Image size 2352x1568. CFP. 45° field of view — 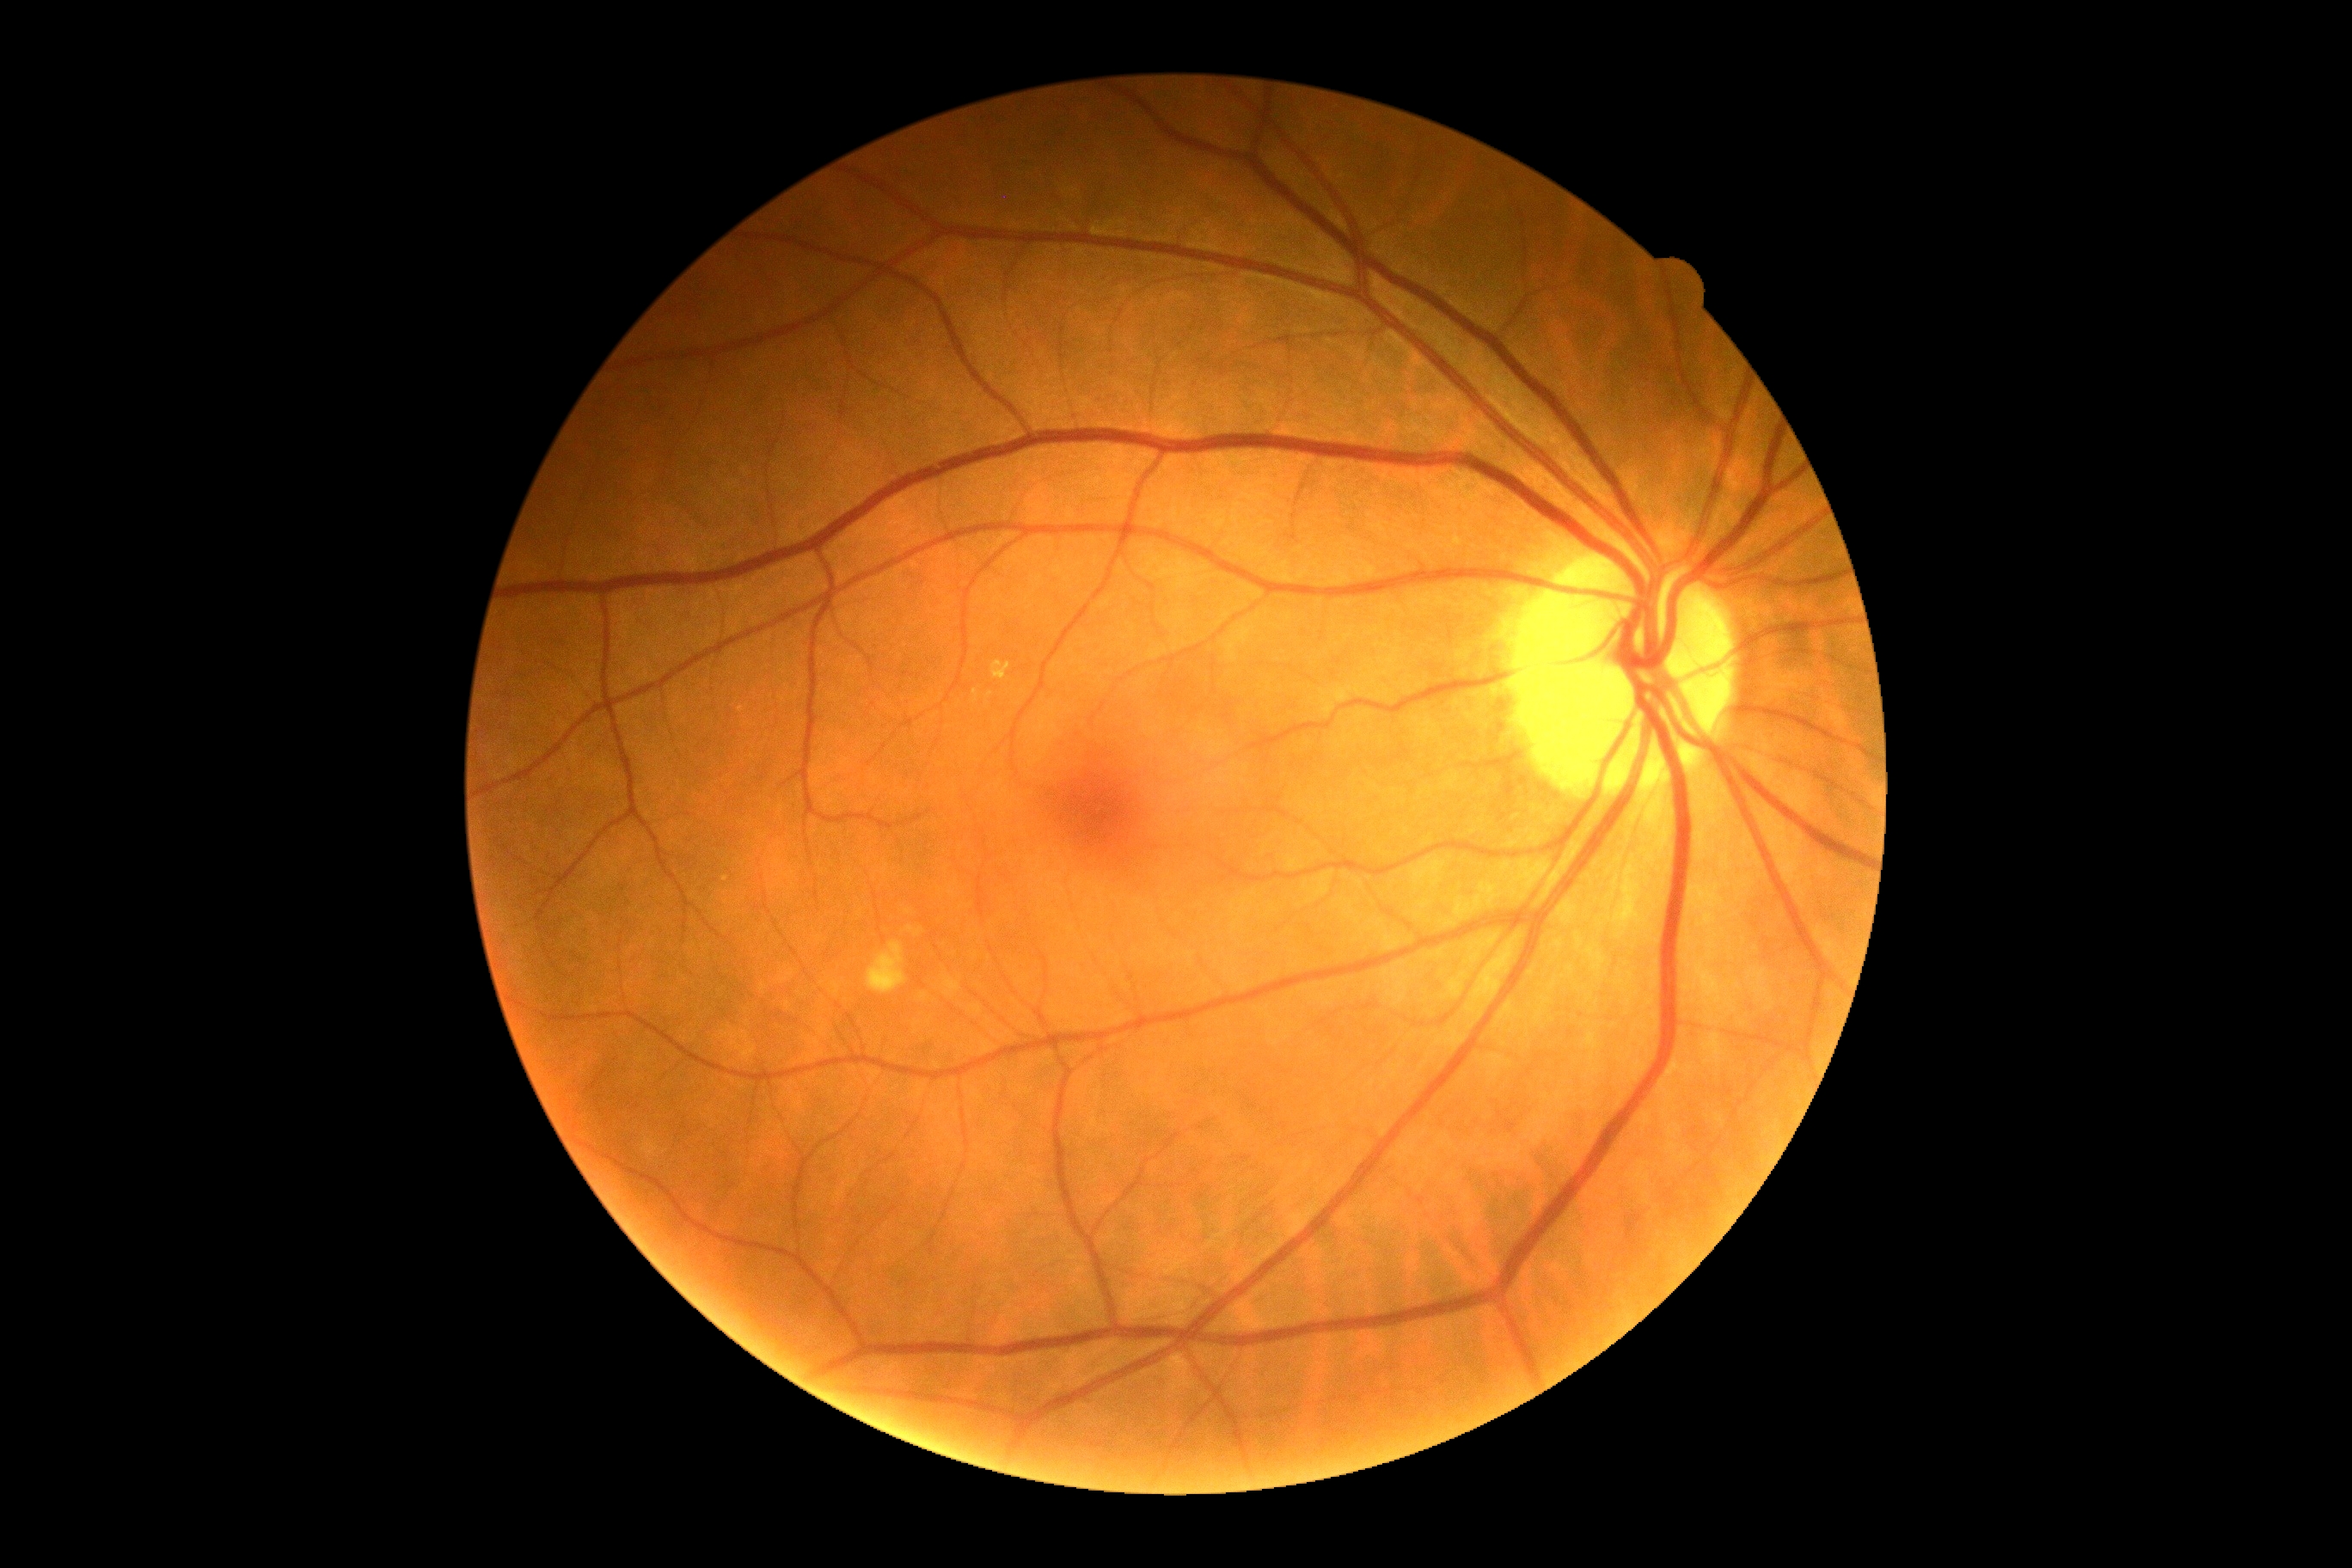 Diabetic retinopathy grade: no apparent retinopathy (0) — no visible signs of diabetic retinopathy.